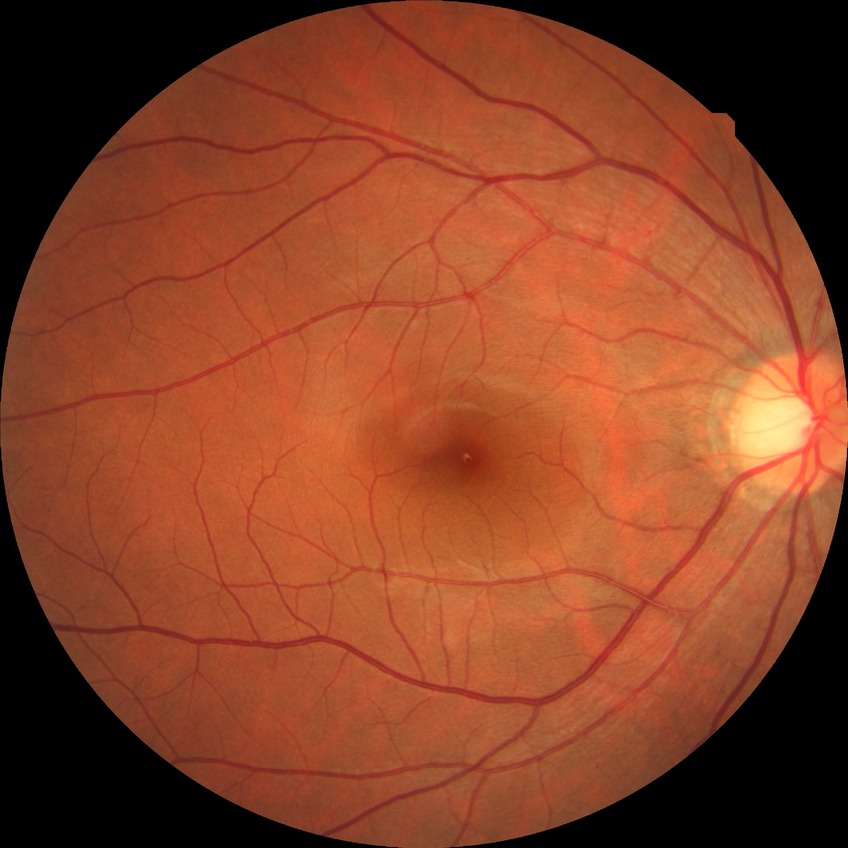
diabetic retinopathy (DR)@NDR (no diabetic retinopathy).